1659 x 2212 pixels:
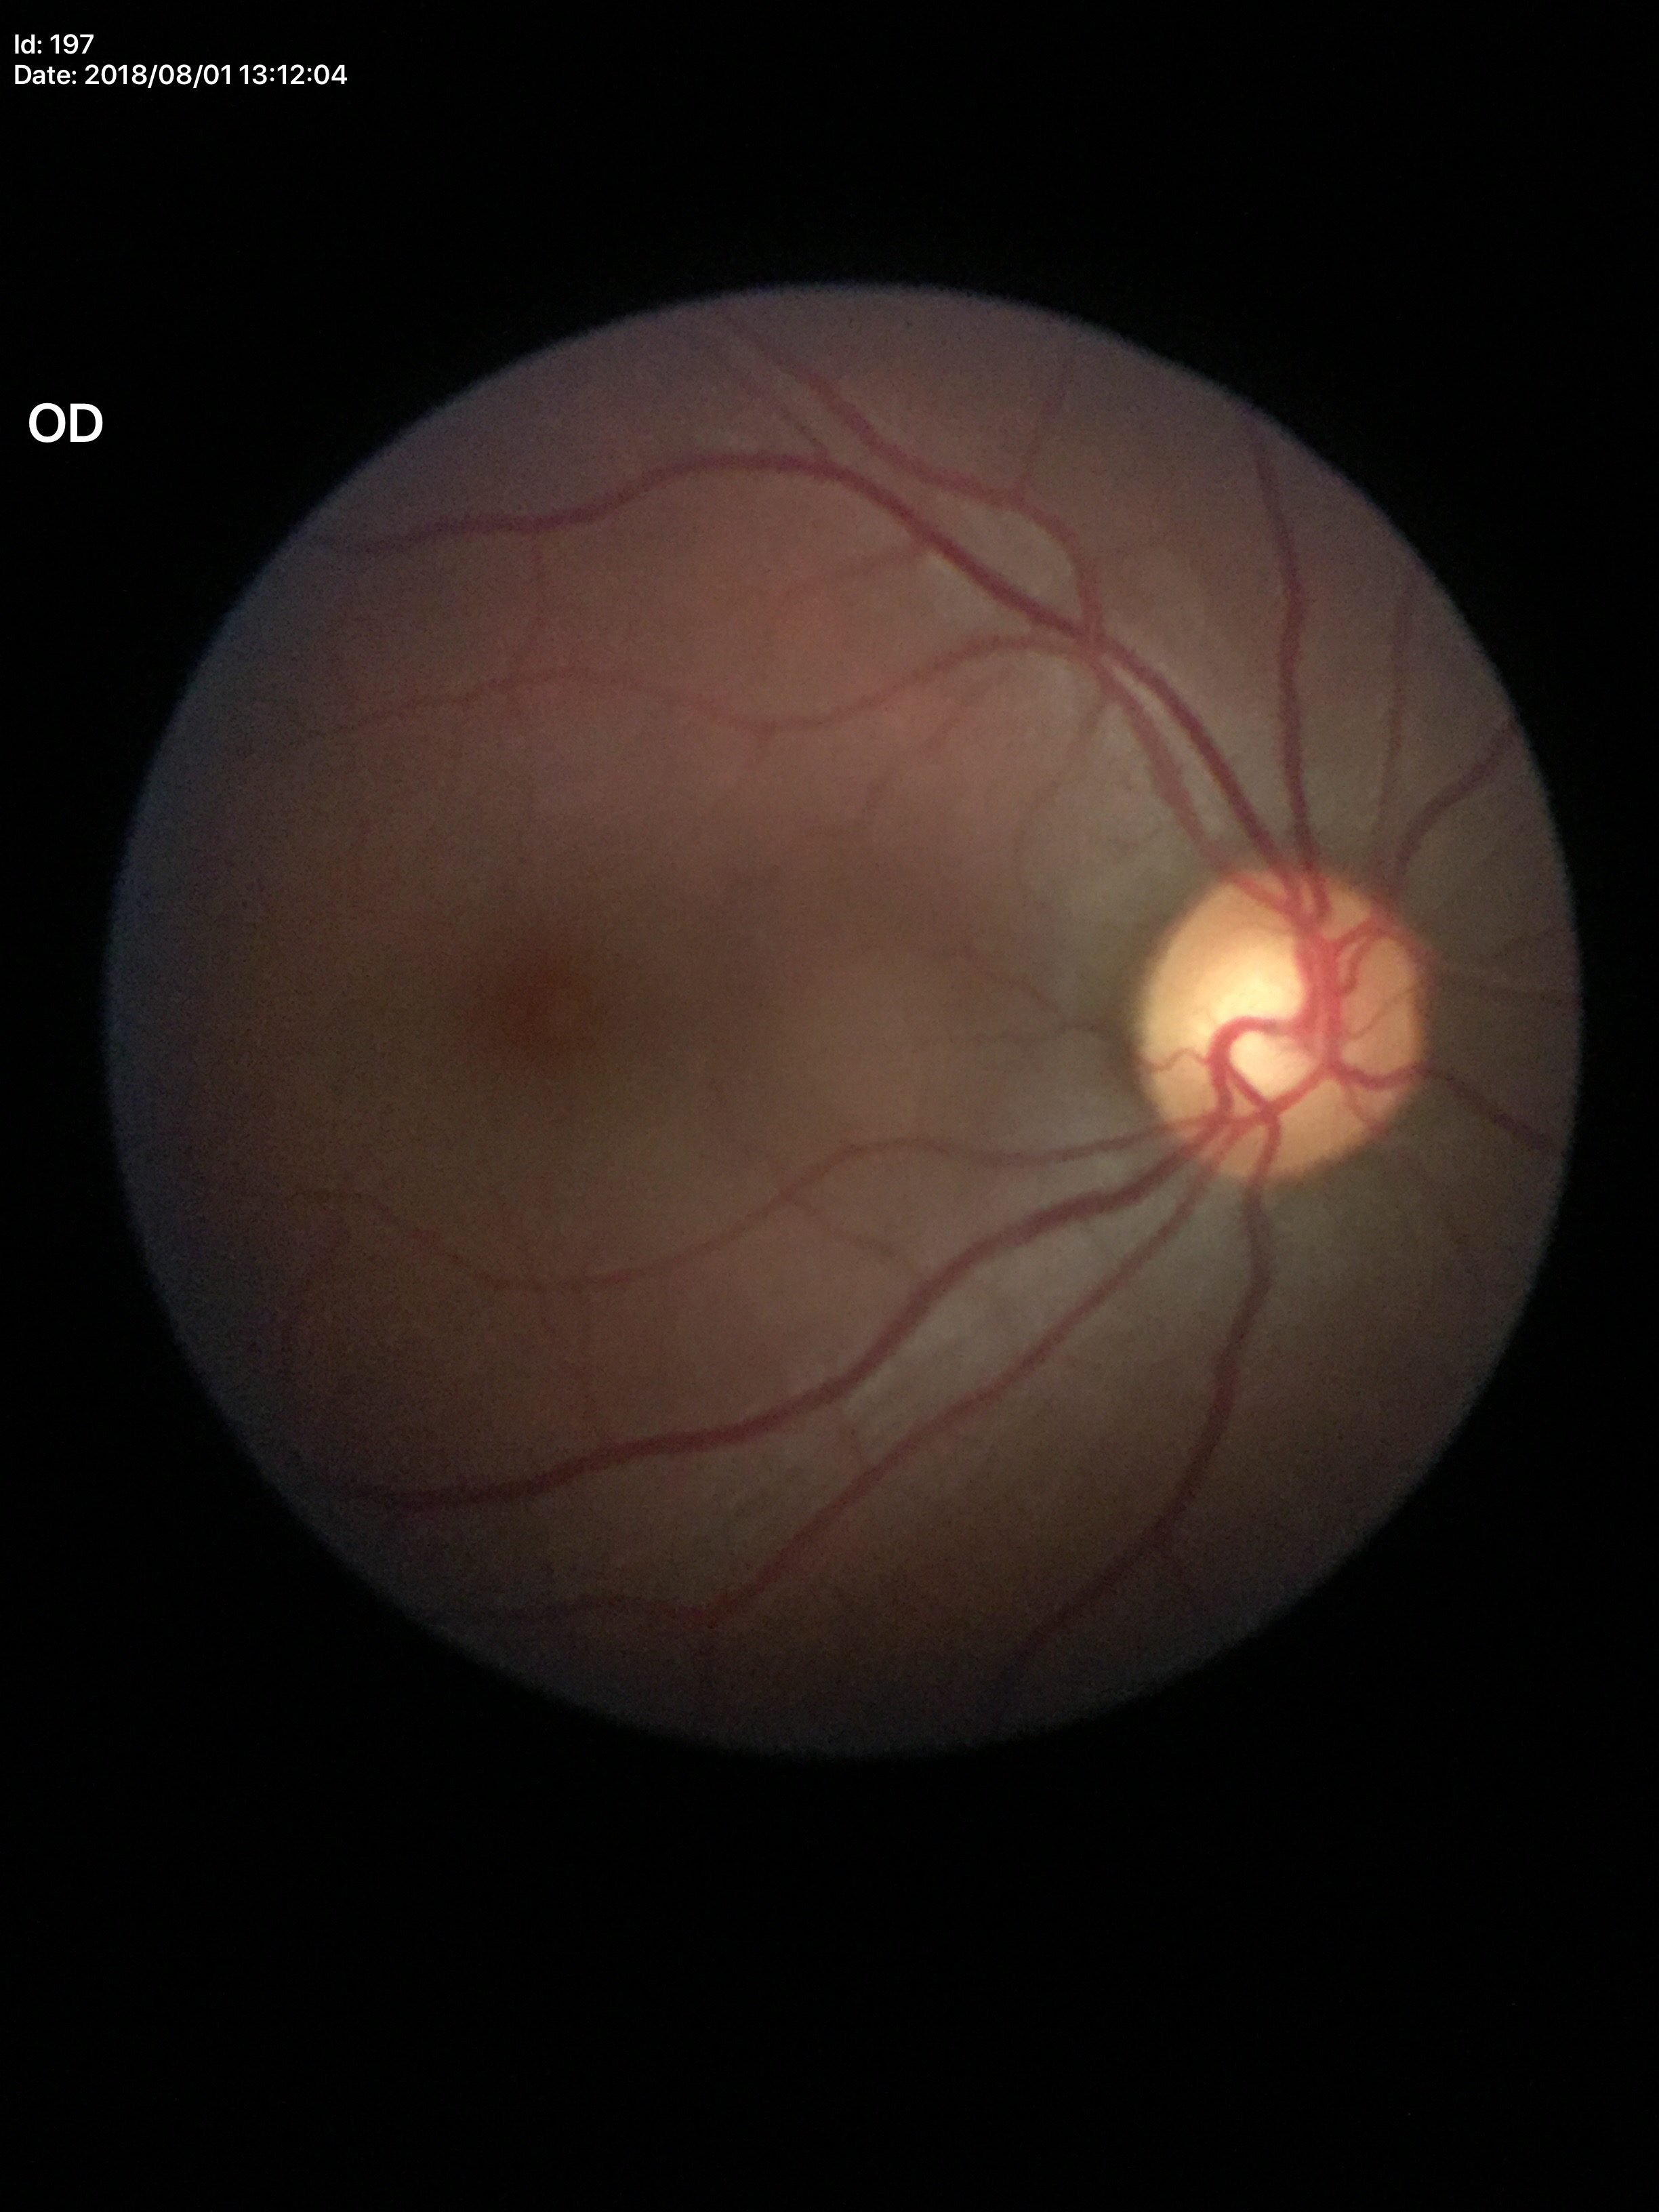
Glaucoma evaluation: suspicious findings, vertical CDR: 0.63, horizontal C/D ratio: 0.56.